Fundus photo: 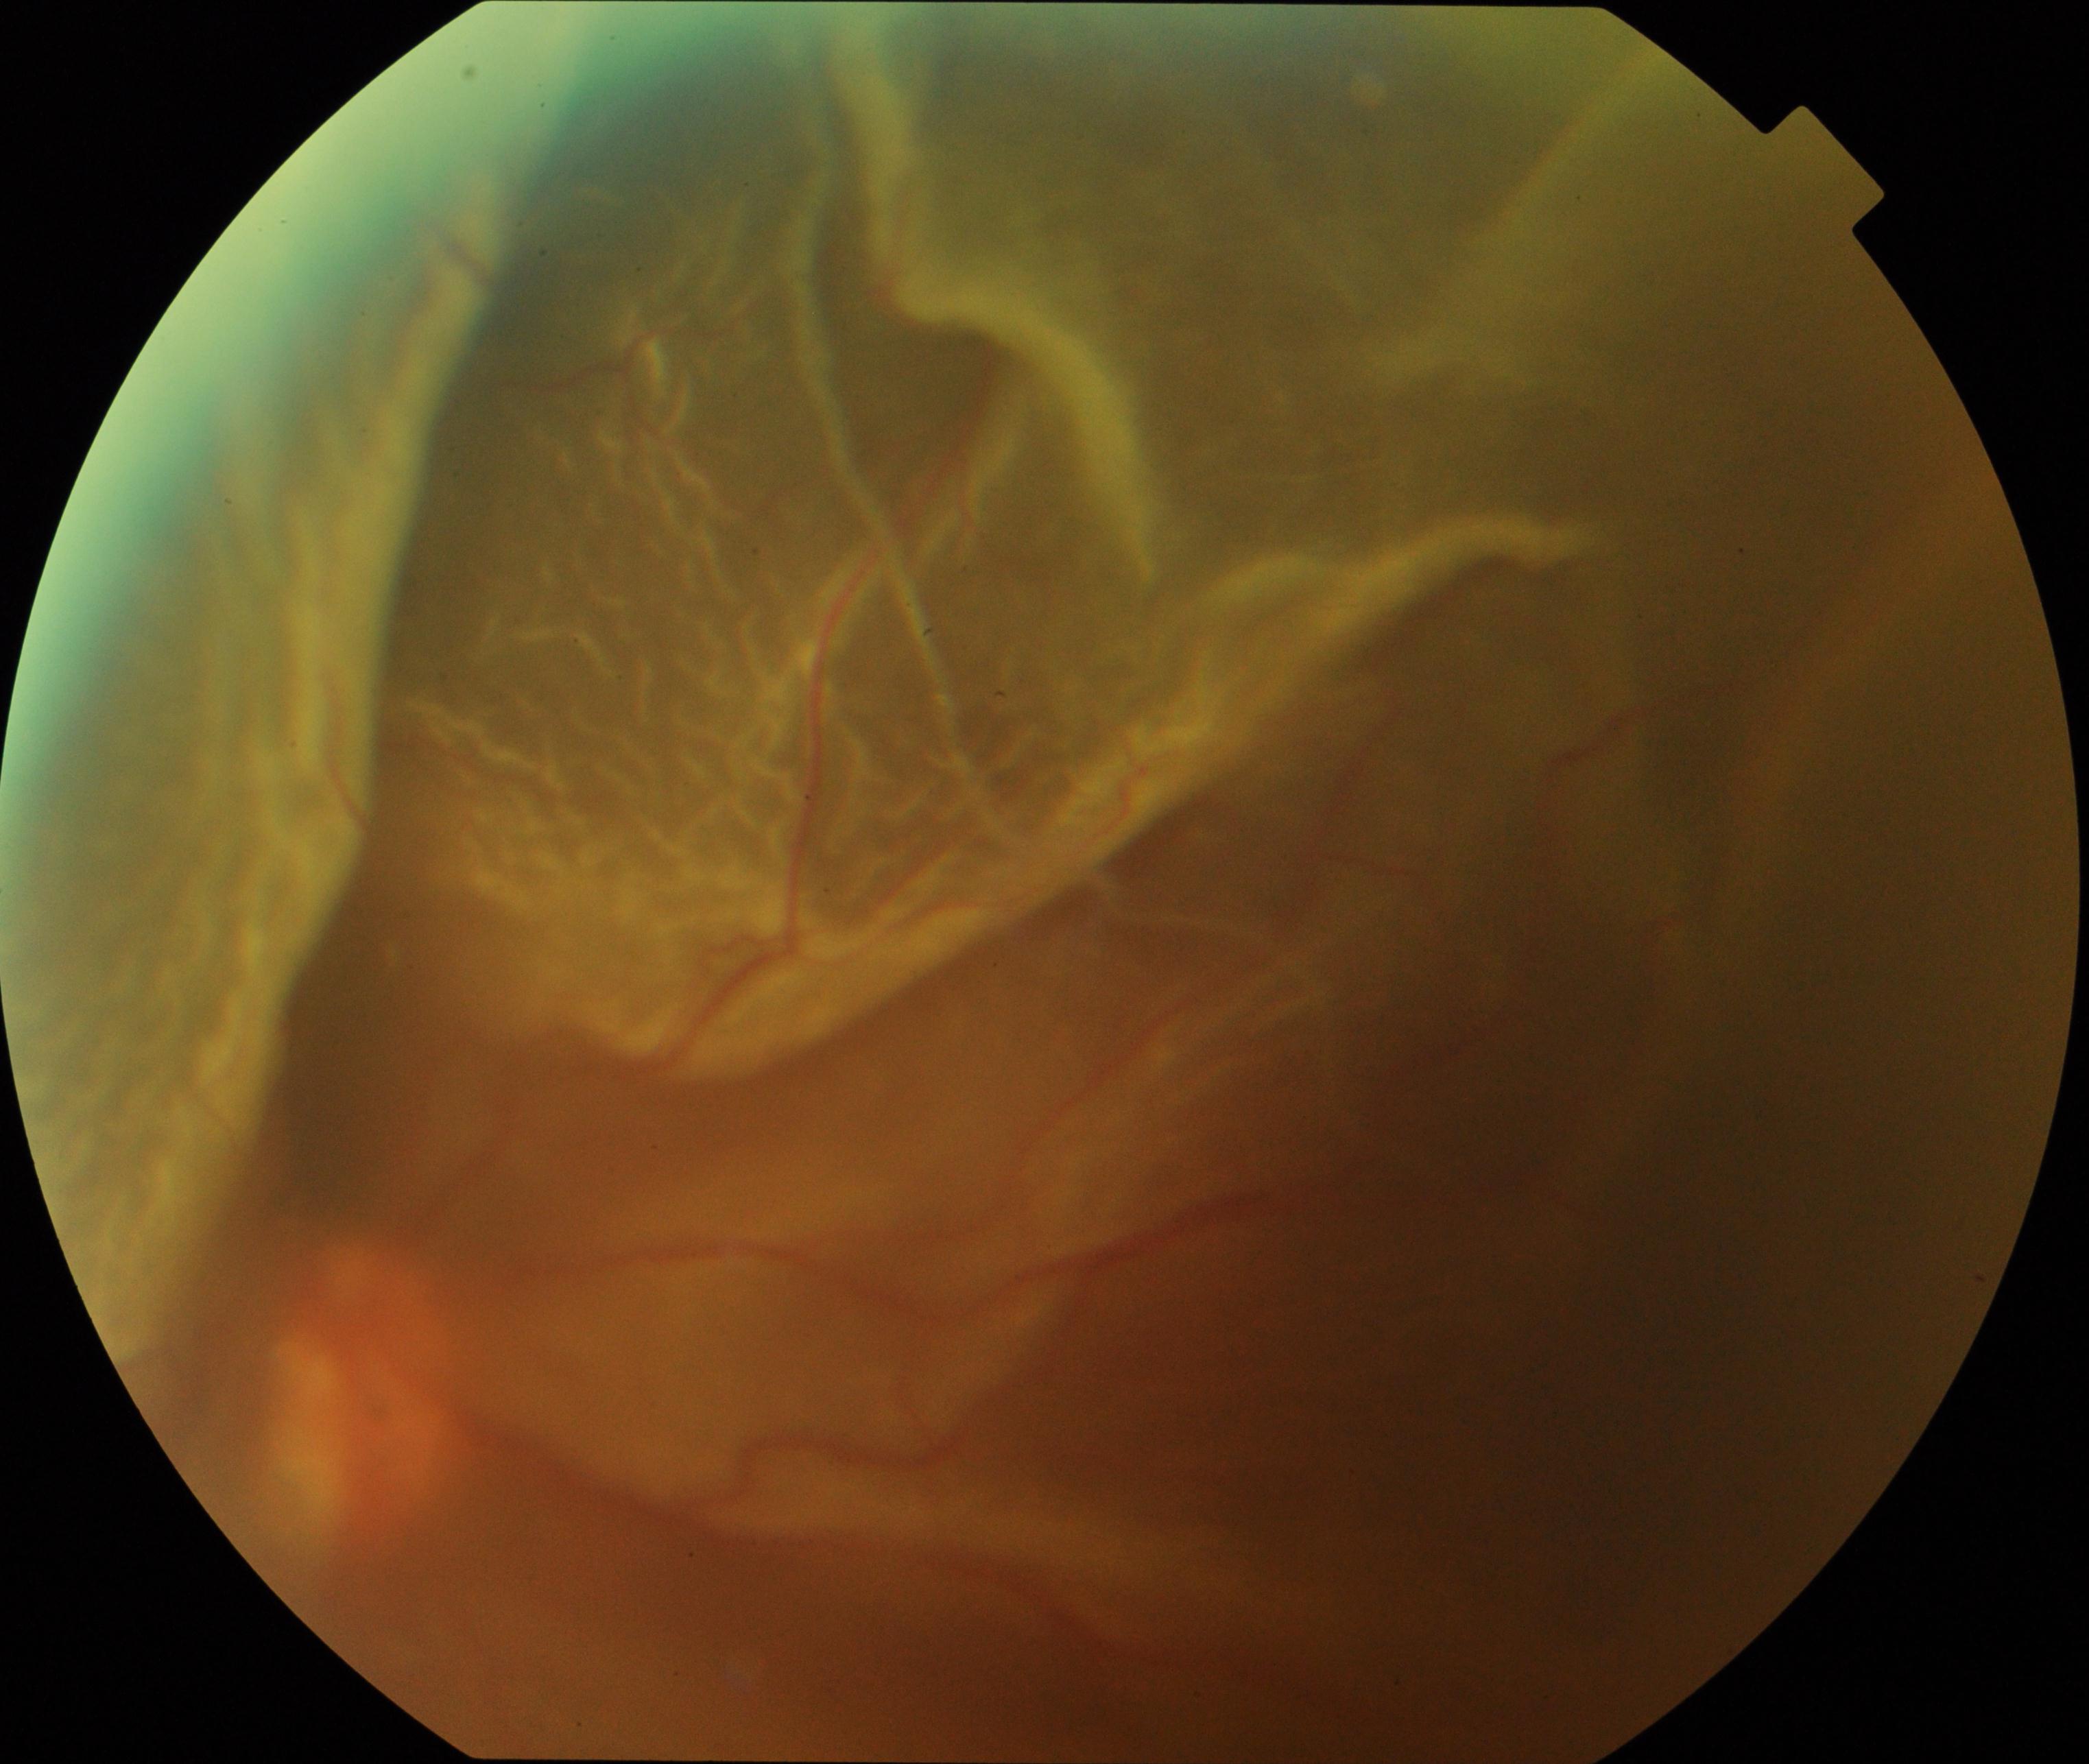 Findings consistent with rhegmatogenous retinal detachment.